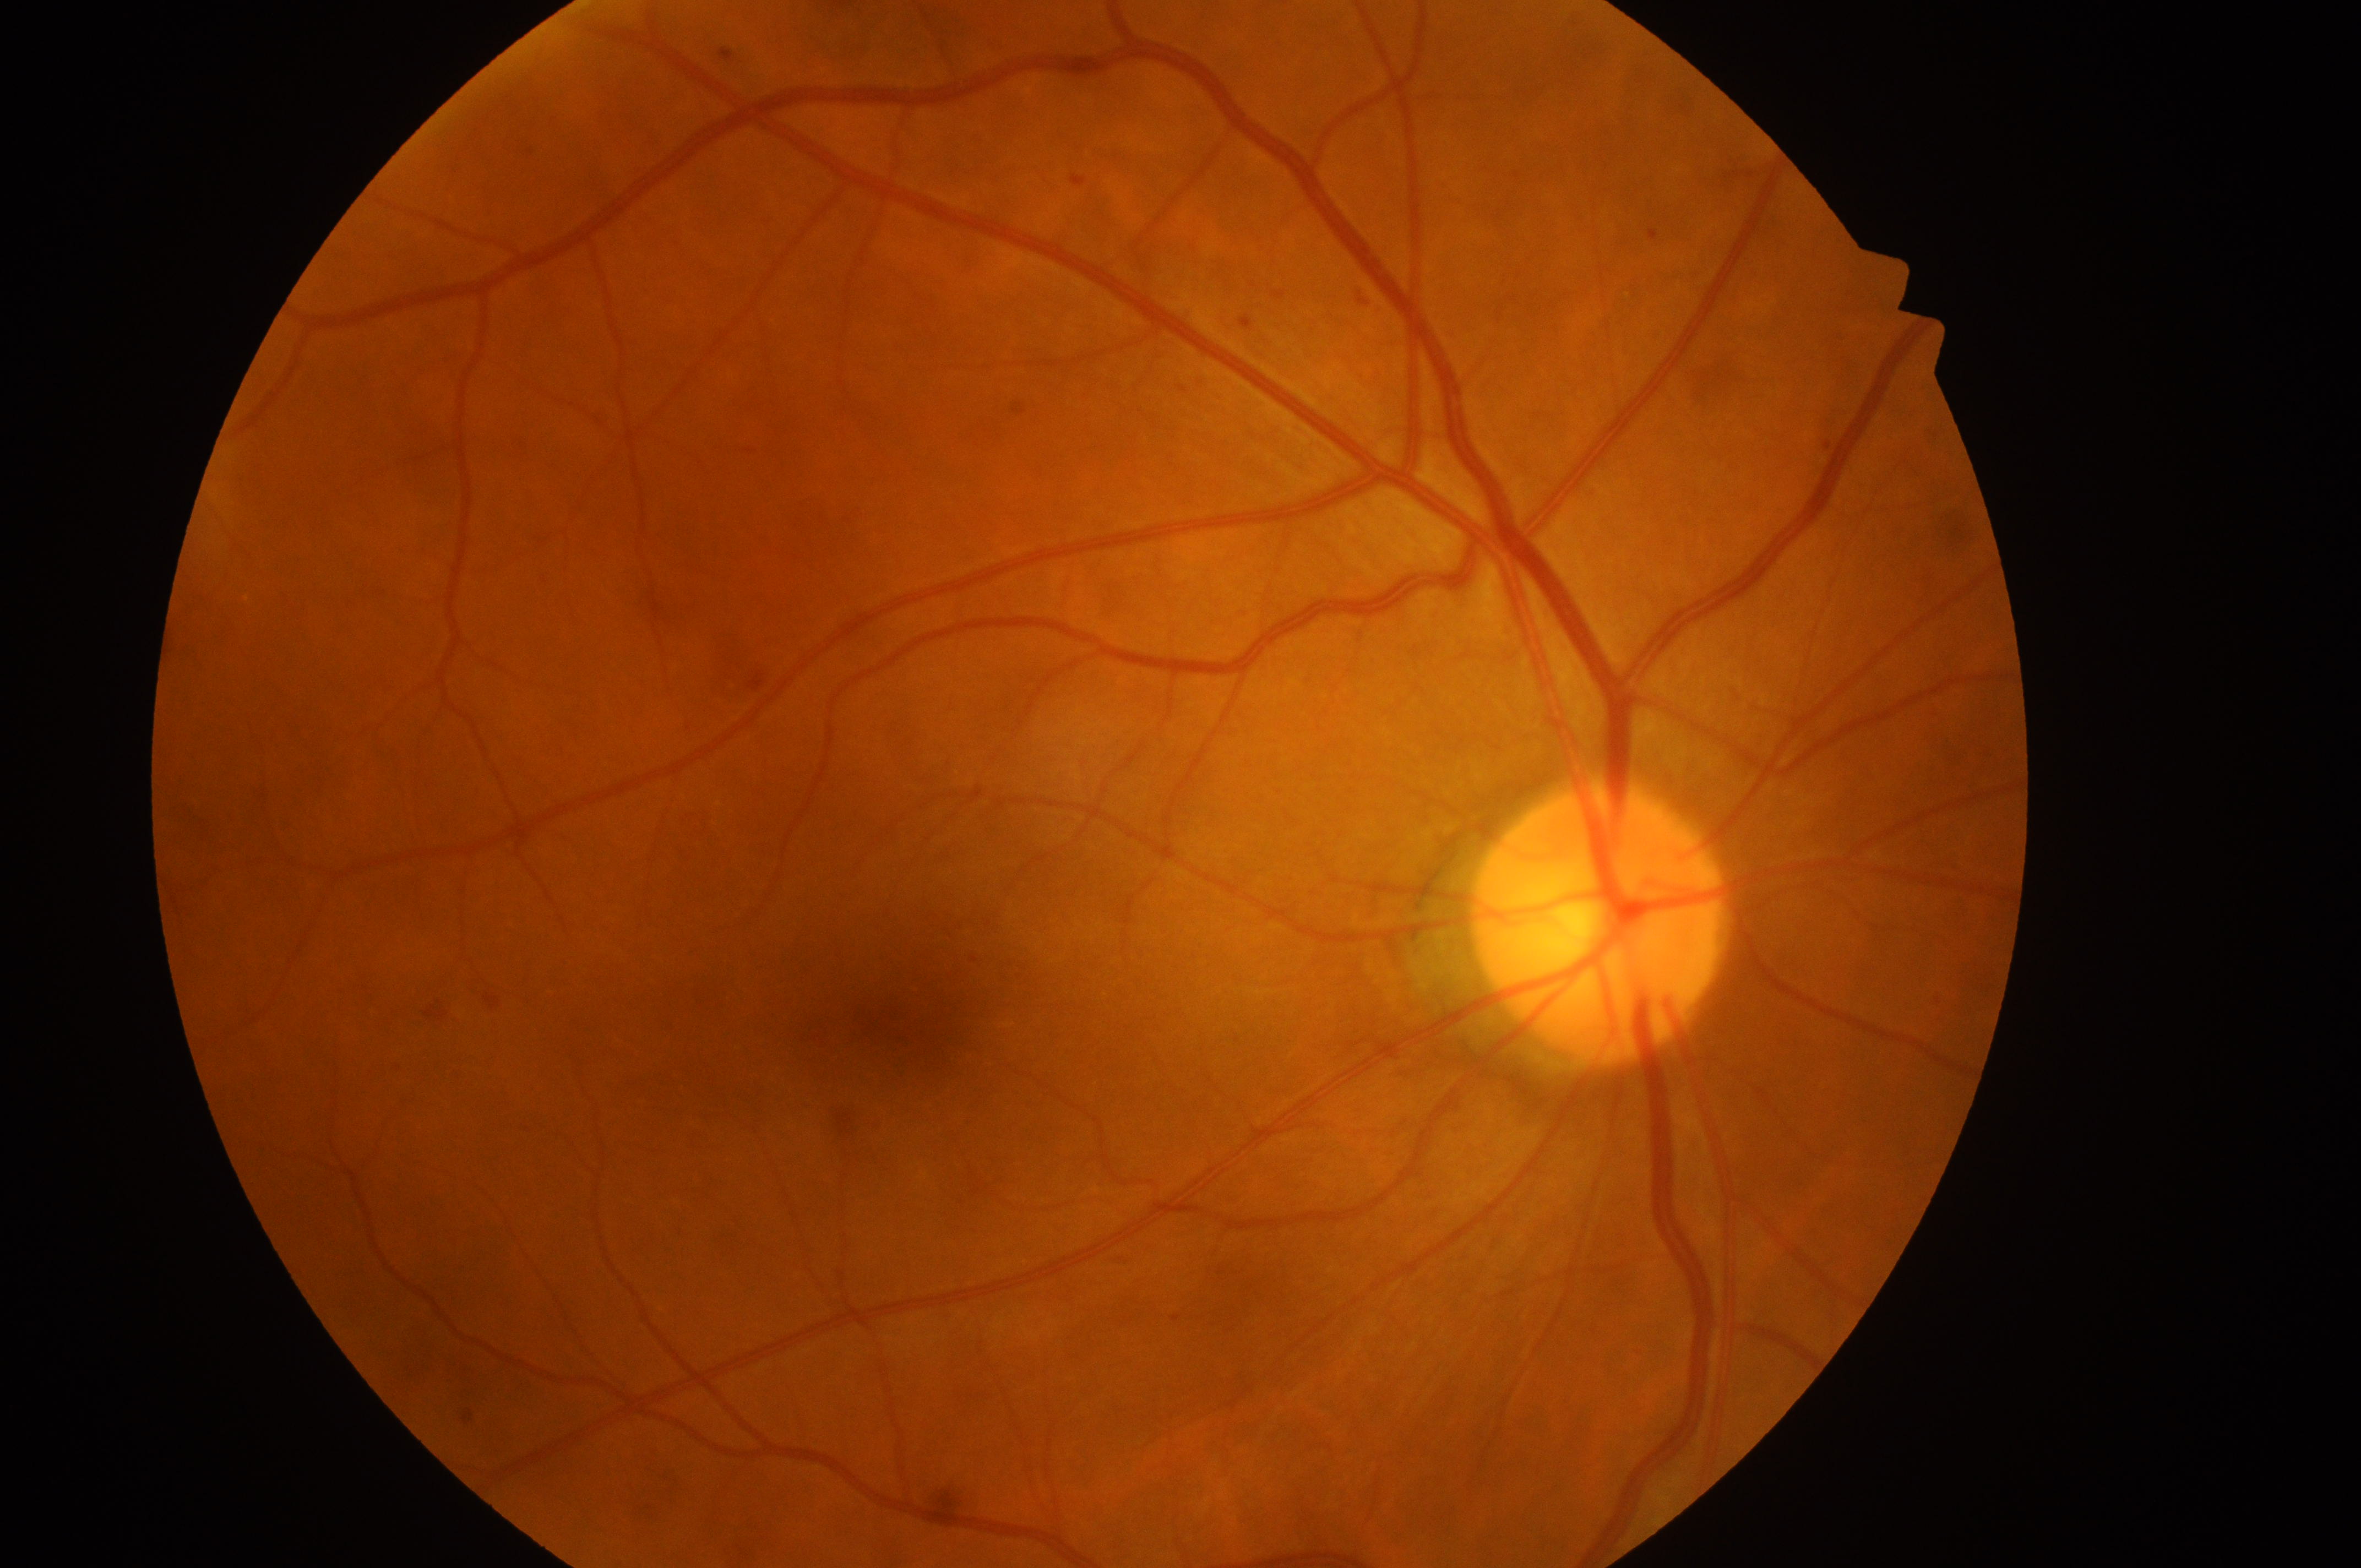
Fovea: 922, 1016.
Diabetic retinopathy (DR) is grade 1 (mild NPDR) — presence of microaneurysms only.
Disease class: non-proliferative diabetic retinopathy.
This is the right eye.
Optic disk located at 1597, 934.
Diabetic macular edema (DME): grade 0 (no risk) — no apparent hard exudates.